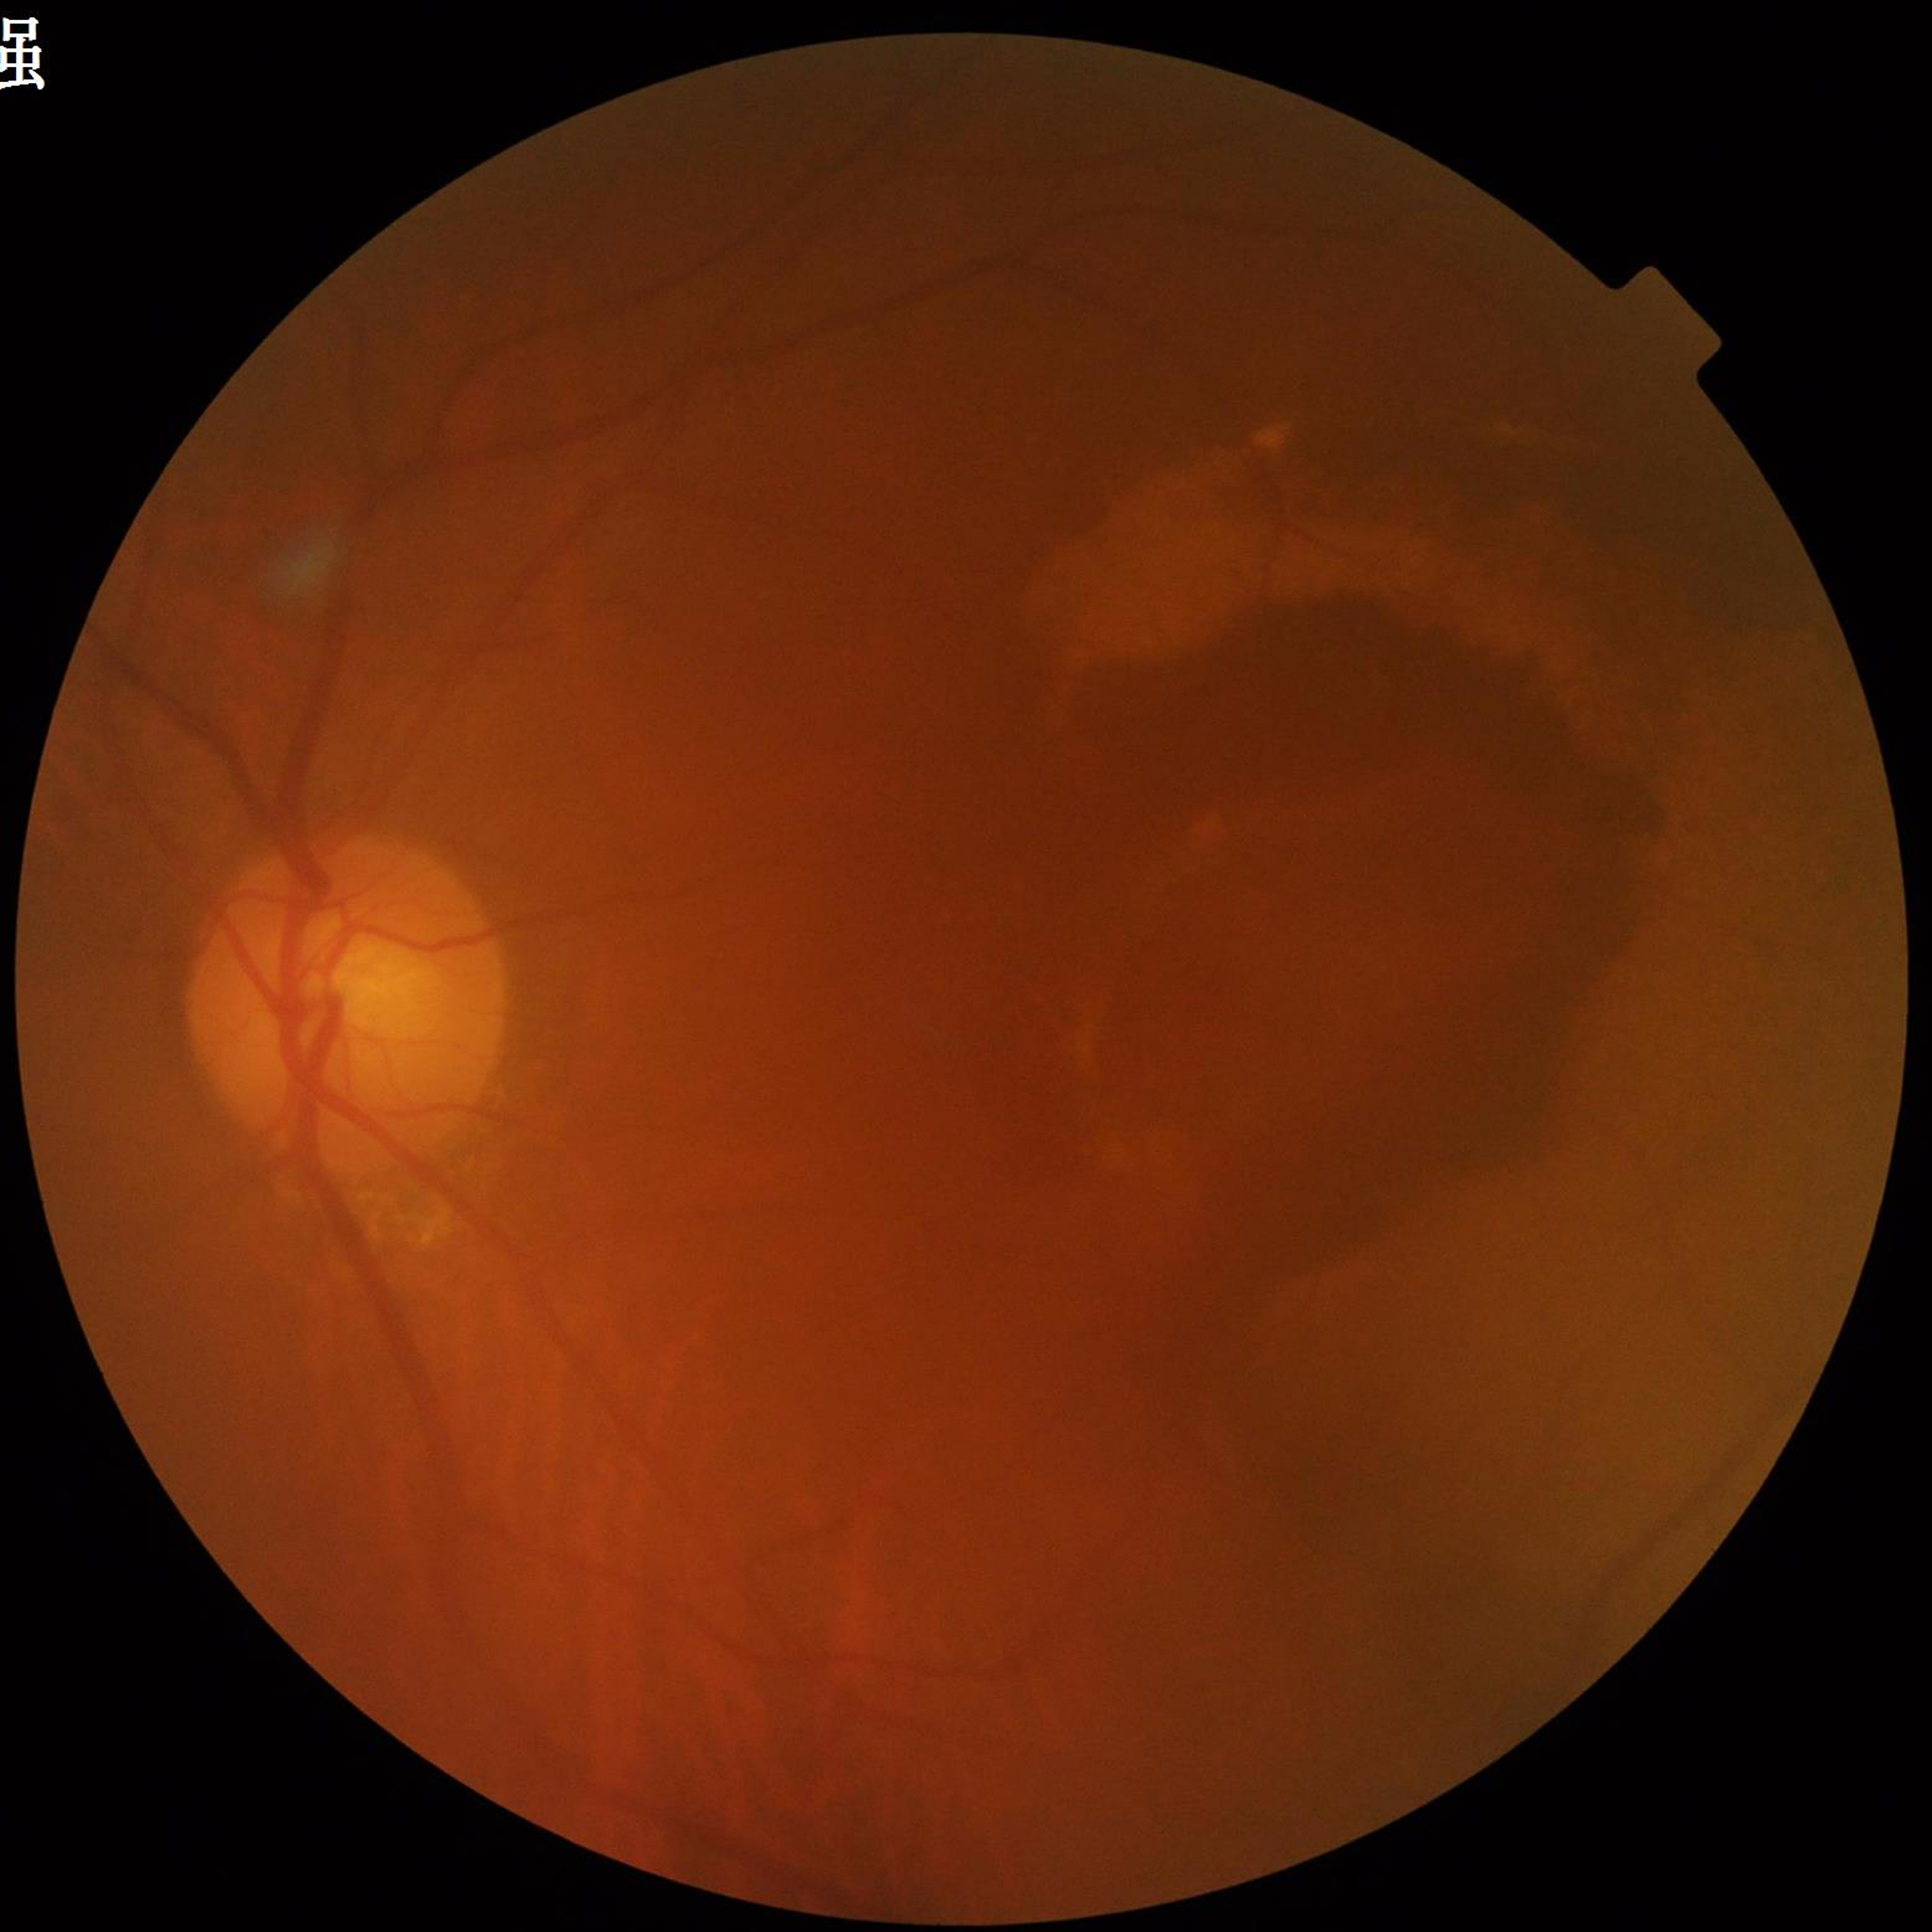
The patient was diagnosed with age-related macular degeneration.